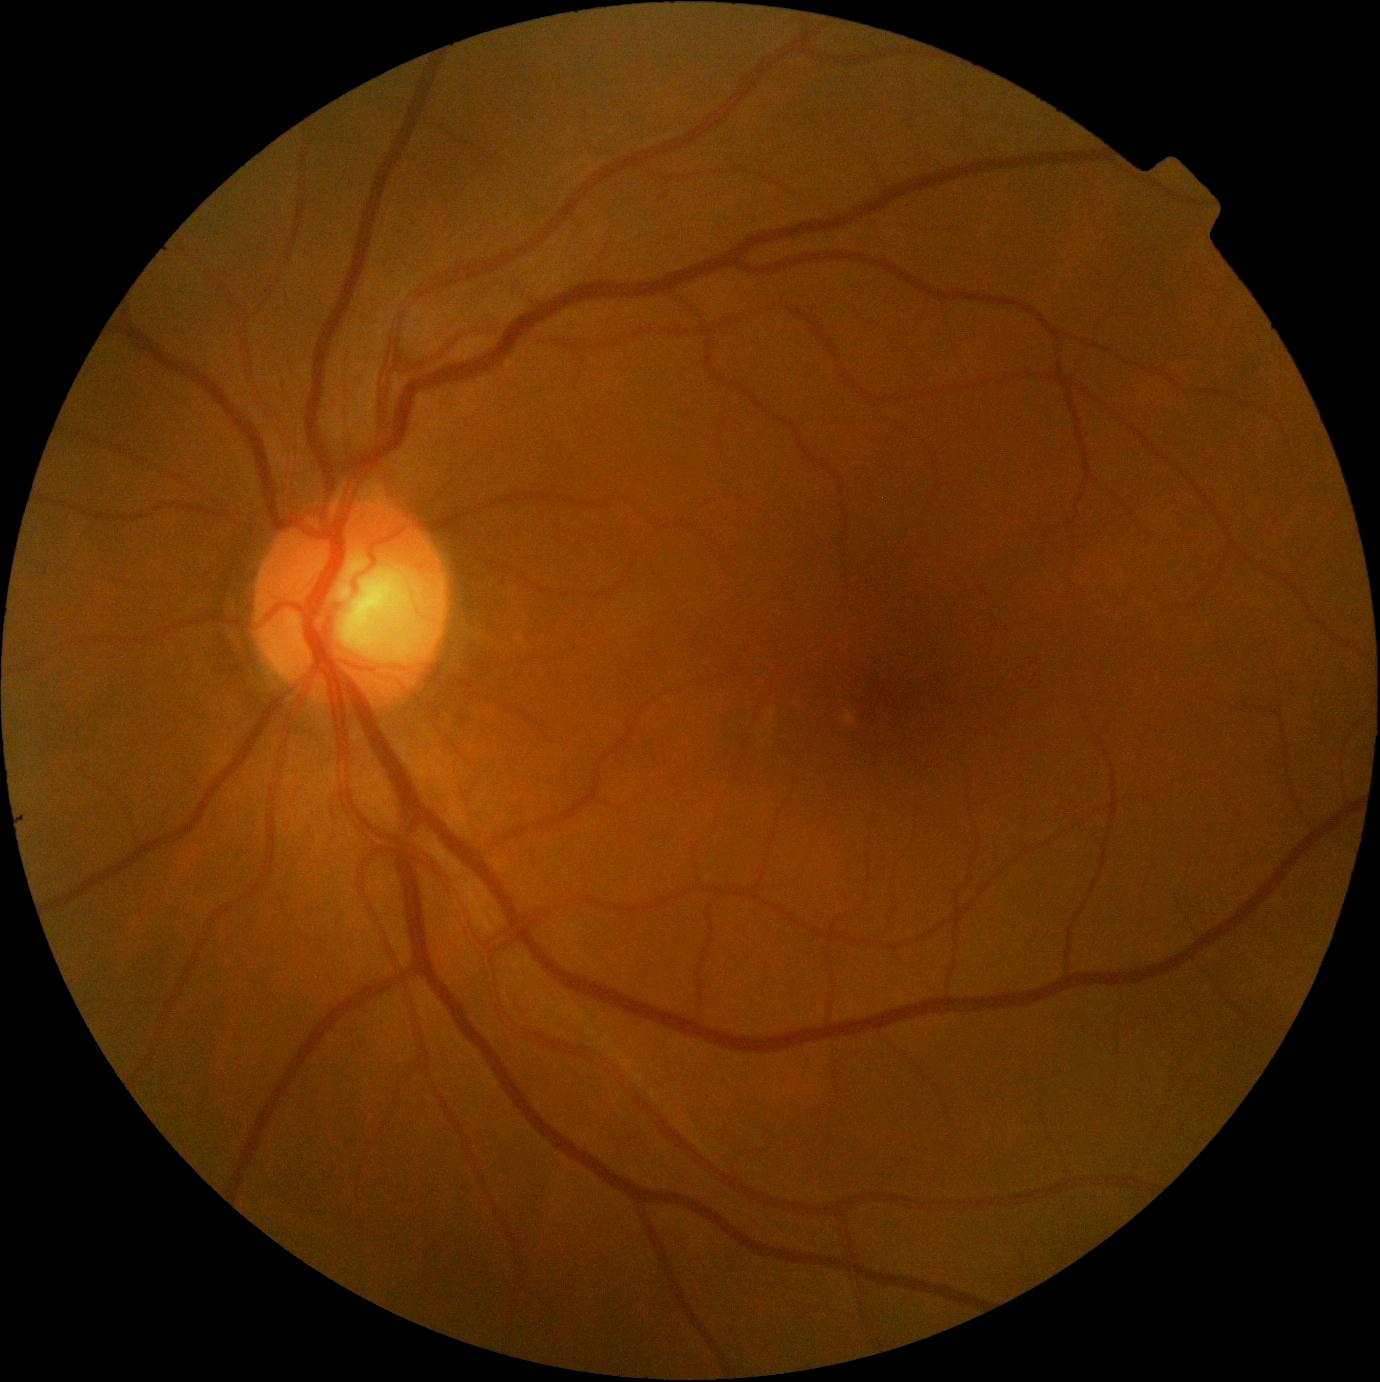
dr_grade: 0